Infant wide-field fundus photograph; 1240 by 1240 pixels — 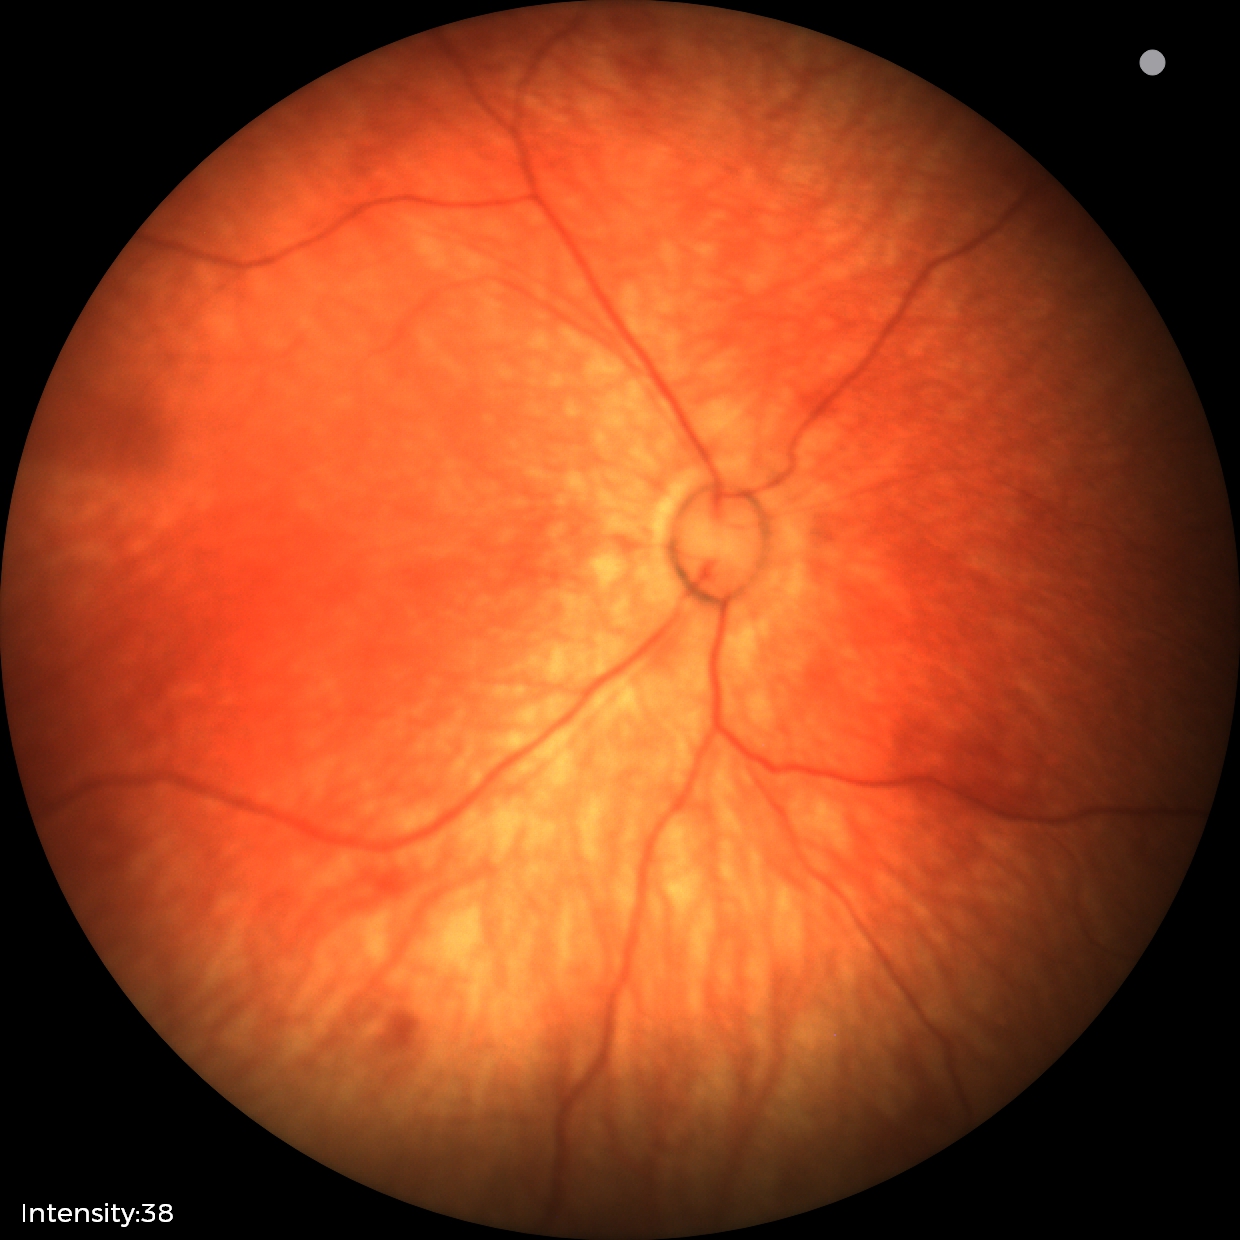 Screening diagnosis: physiological retinal finding.